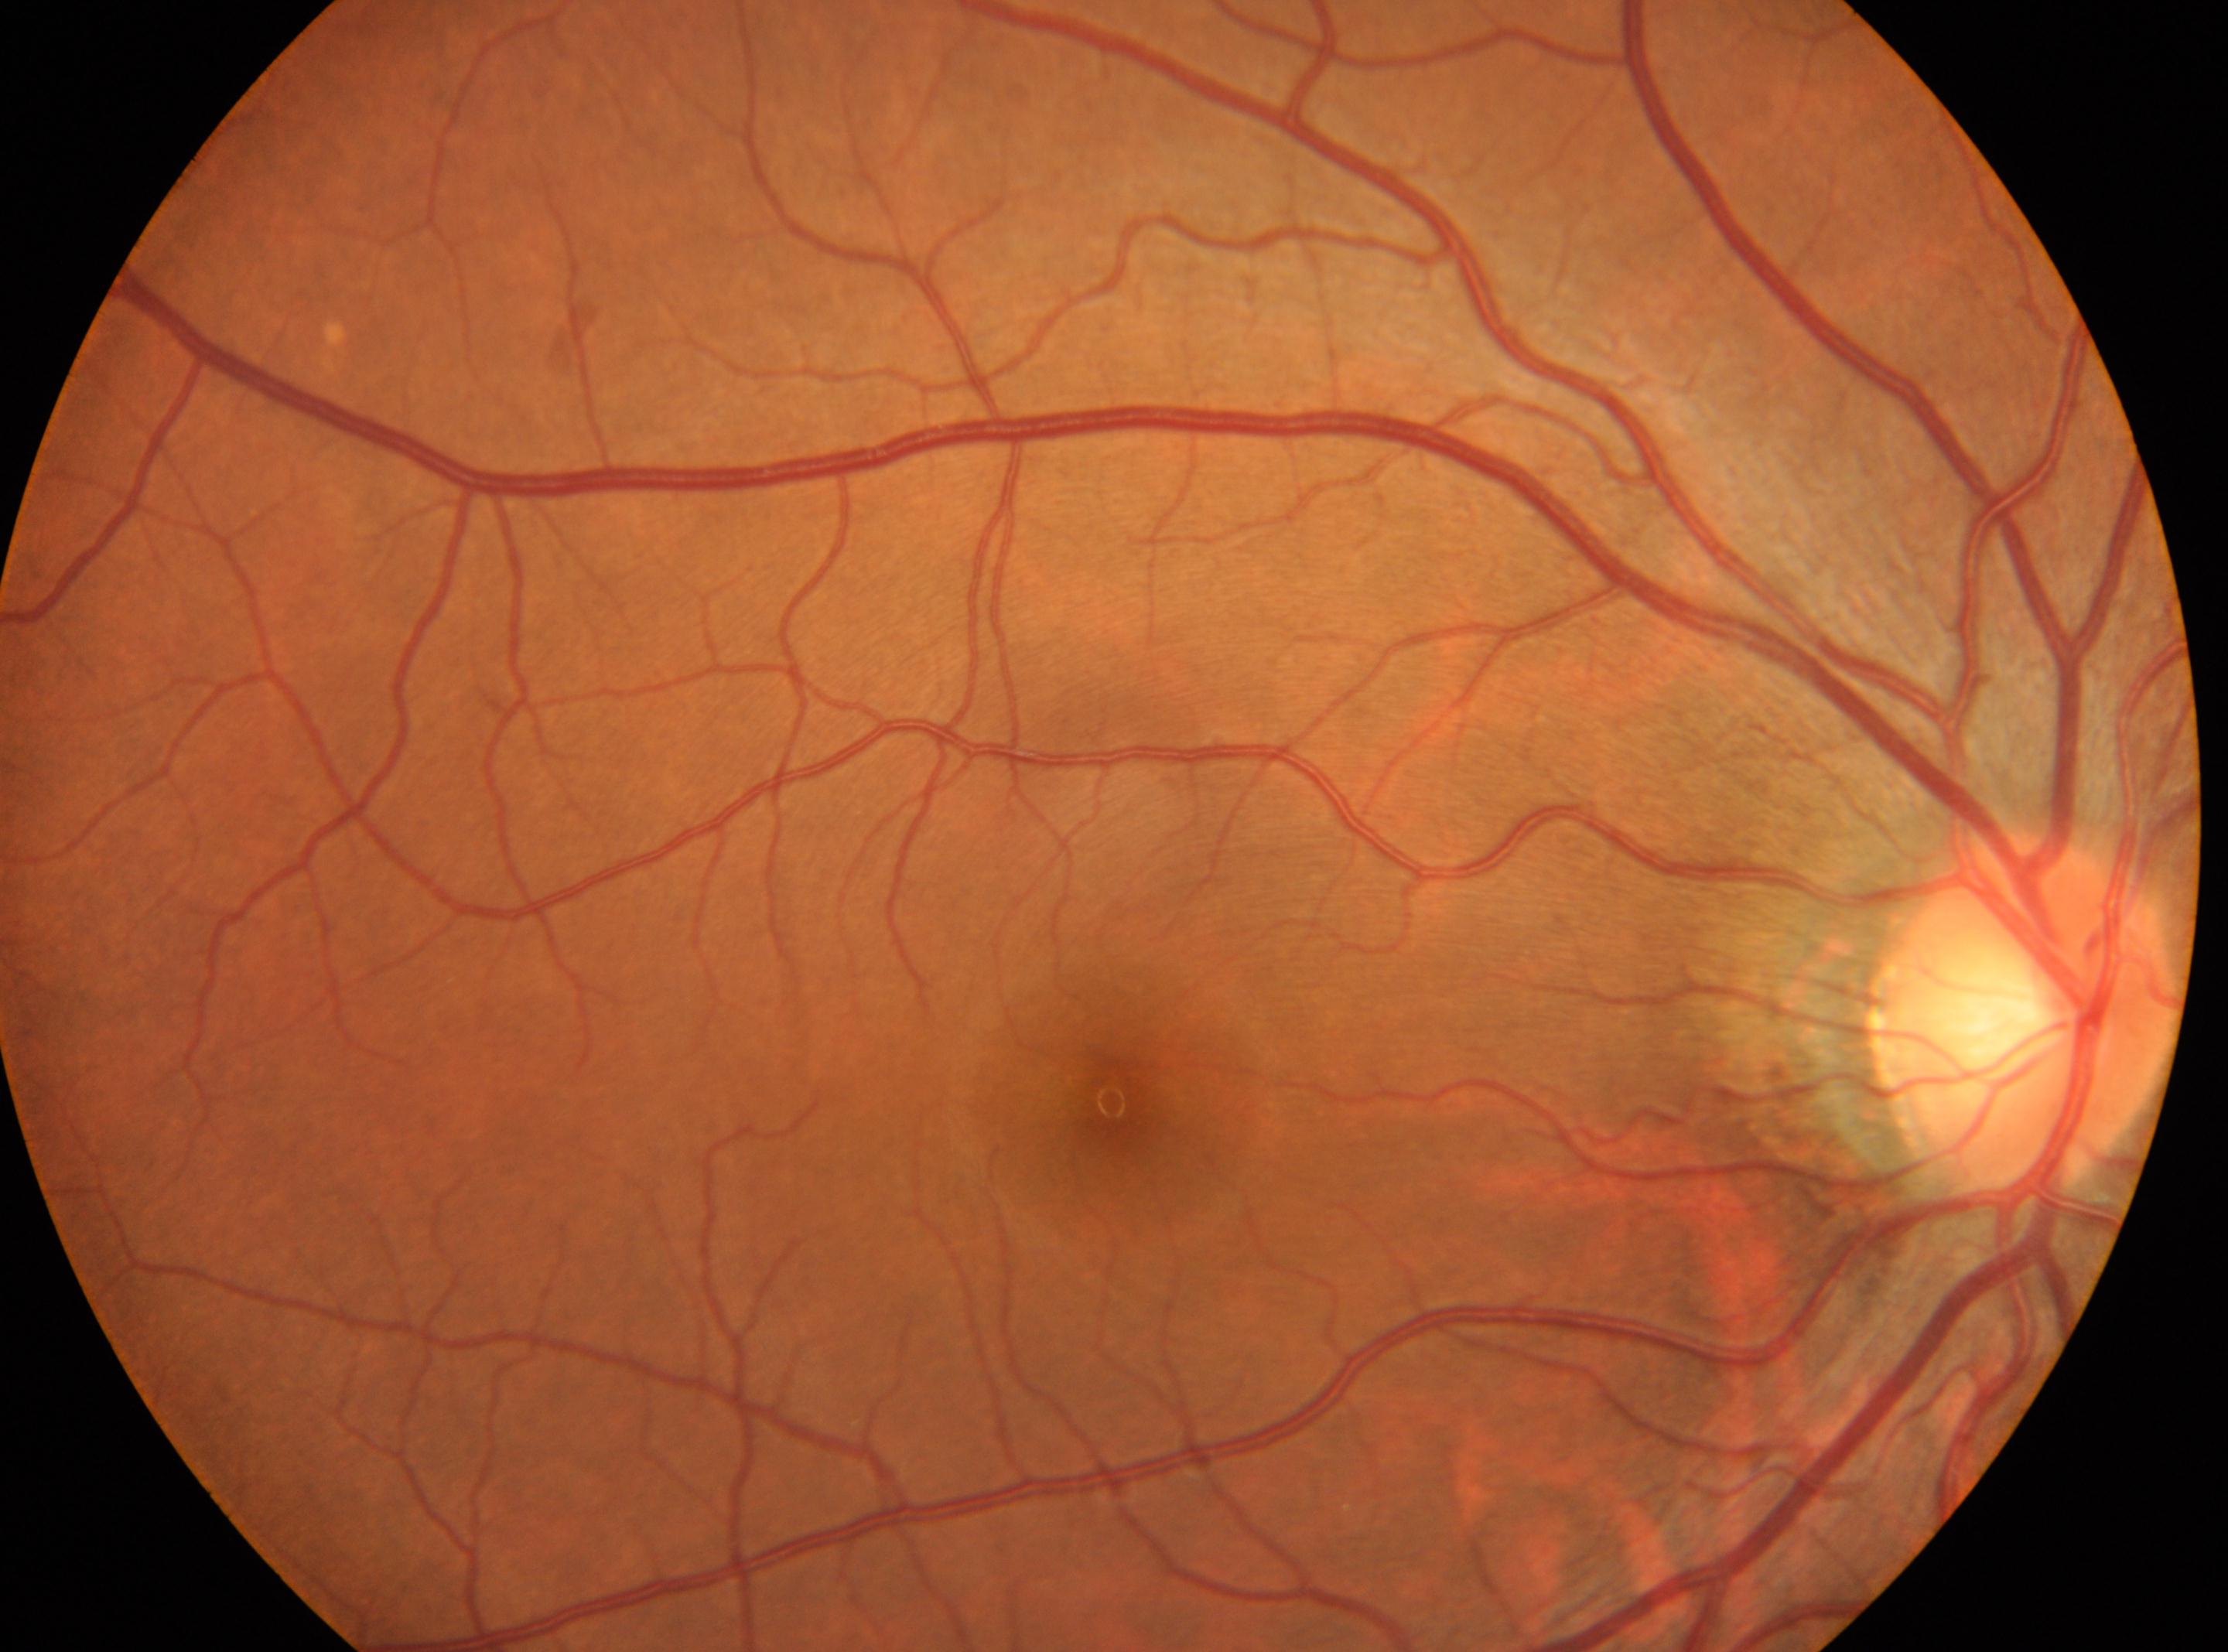 Retinopathy: grade 0. The image shows the OD. ONH located at (2025, 1012). Fovea center located at (1111, 1101).